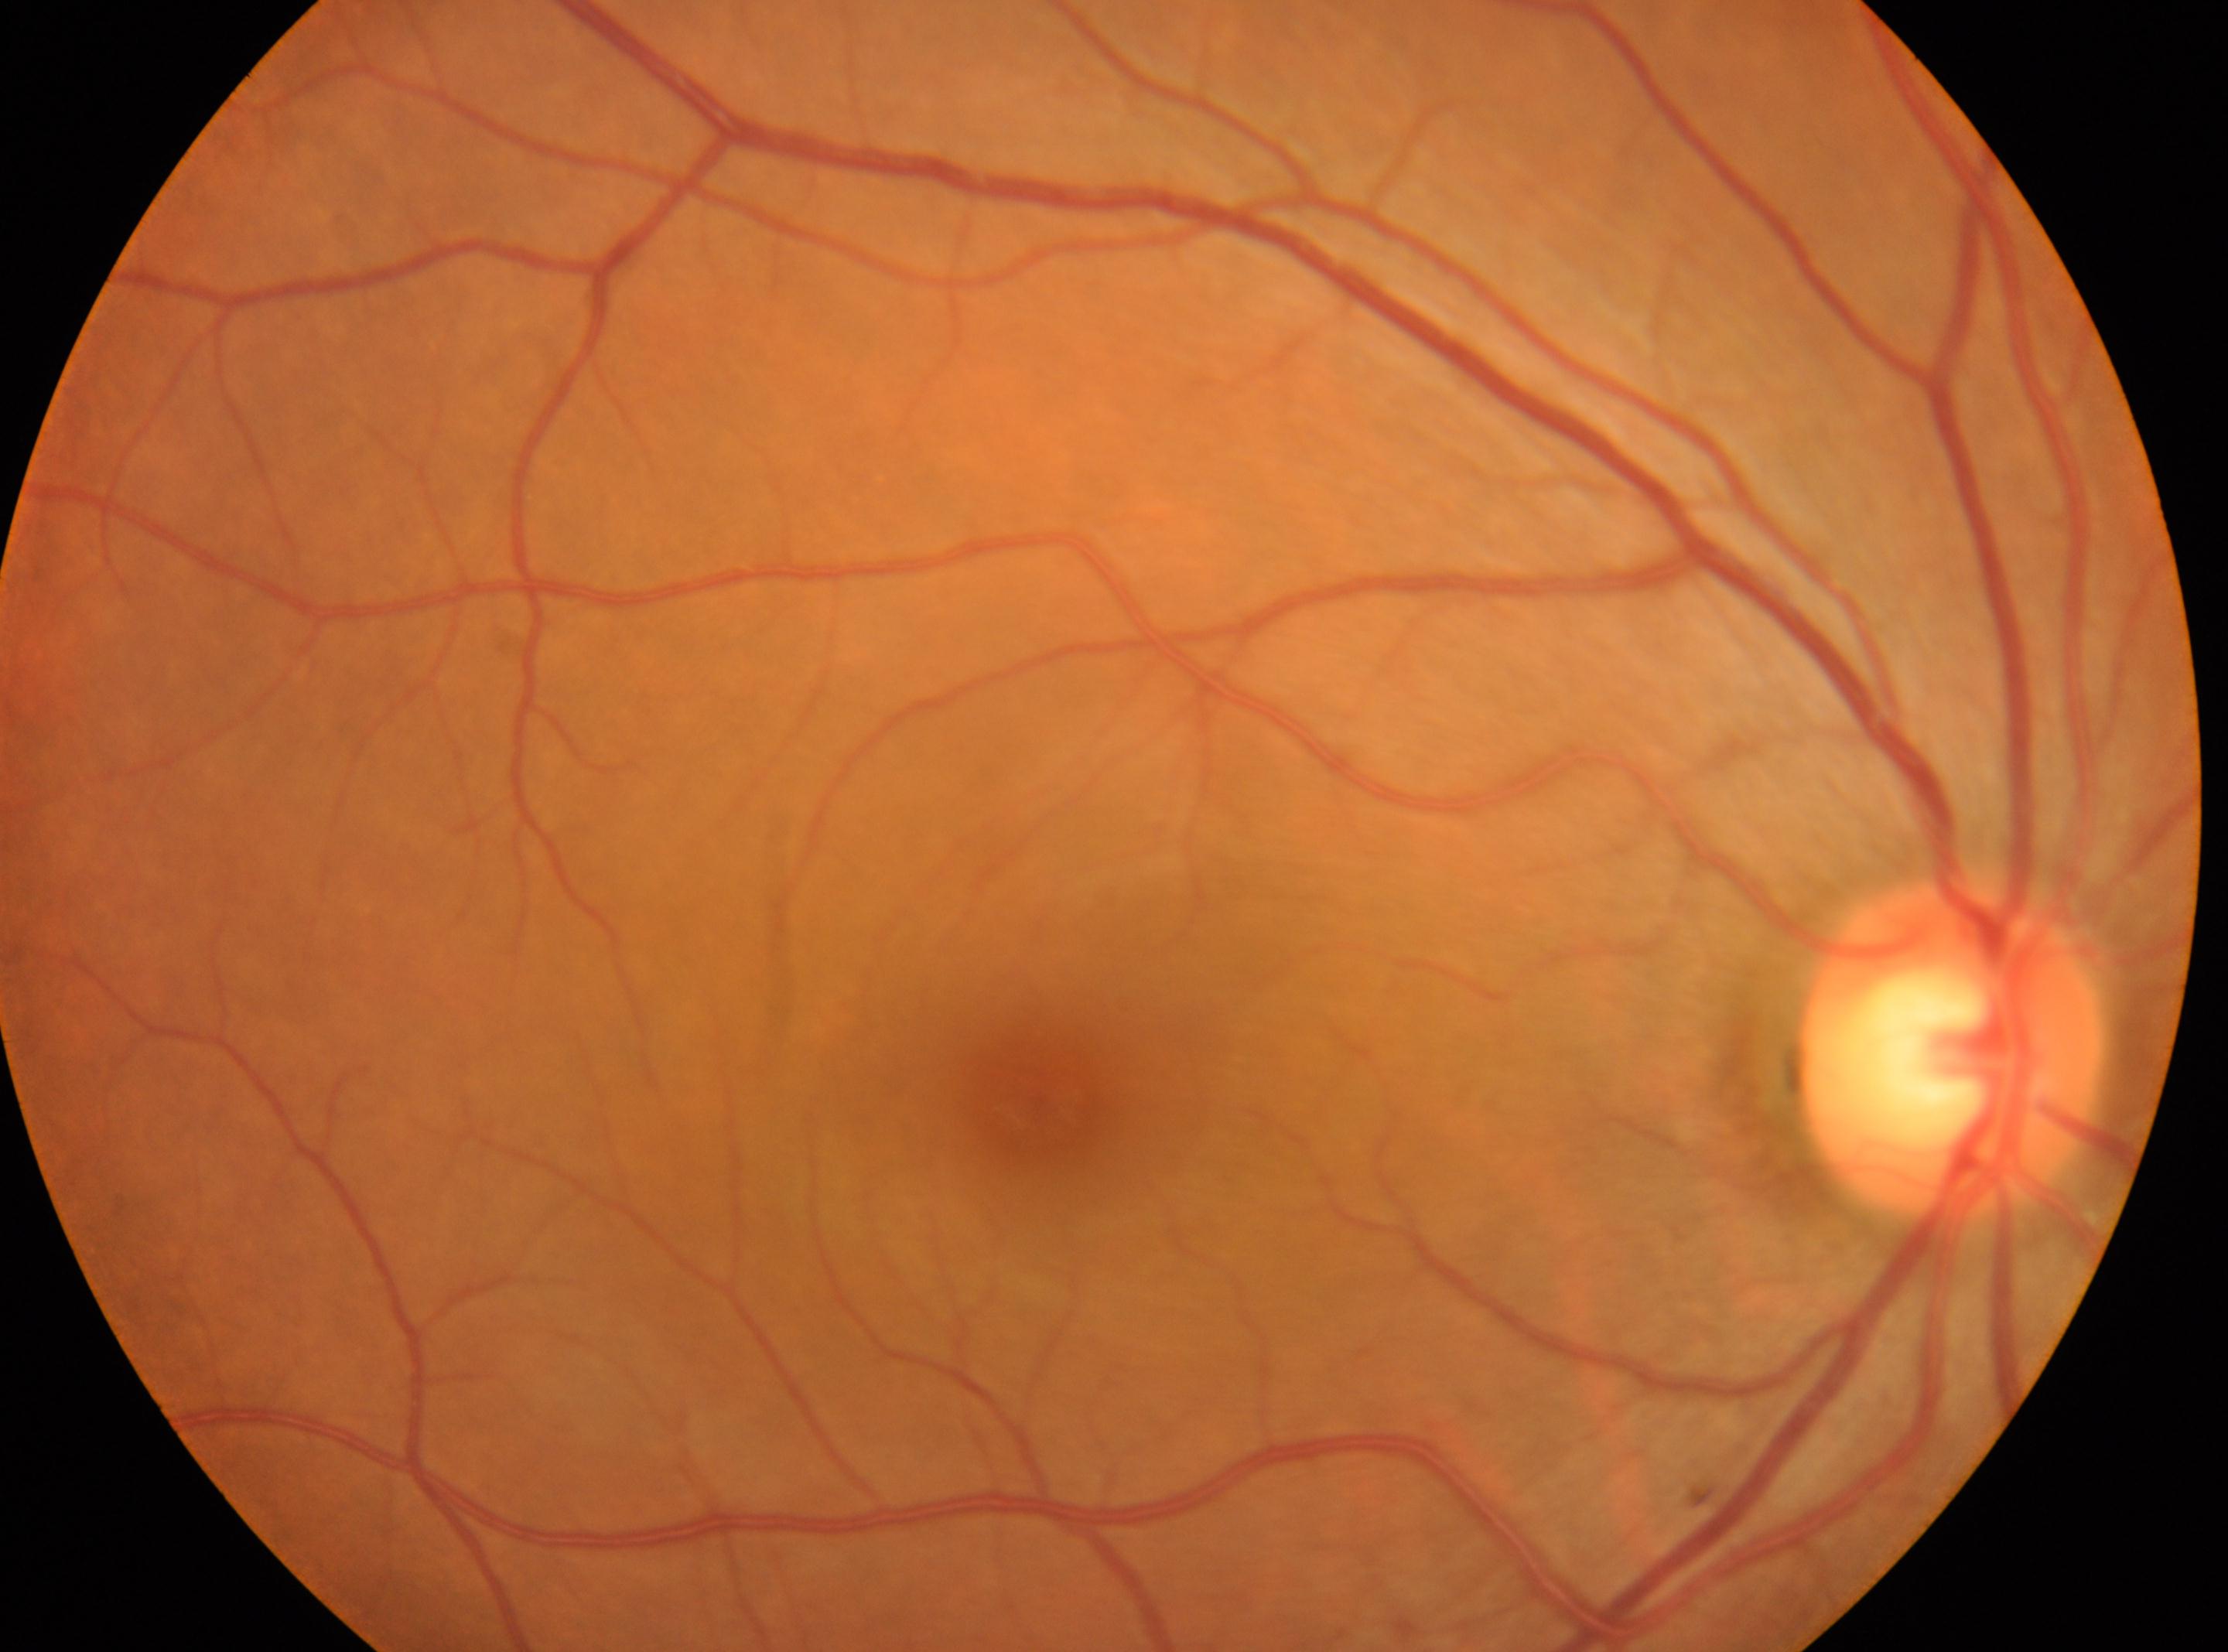
The image shows the right eye.
No diabetic retinal disease findings.
DR severity: grade 0 (no apparent retinopathy) — no visible signs of diabetic retinopathy.
Optic disc: (x=1953, y=1046).
The fovea center is at (x=1043, y=1104).